FOV: 45 degrees: 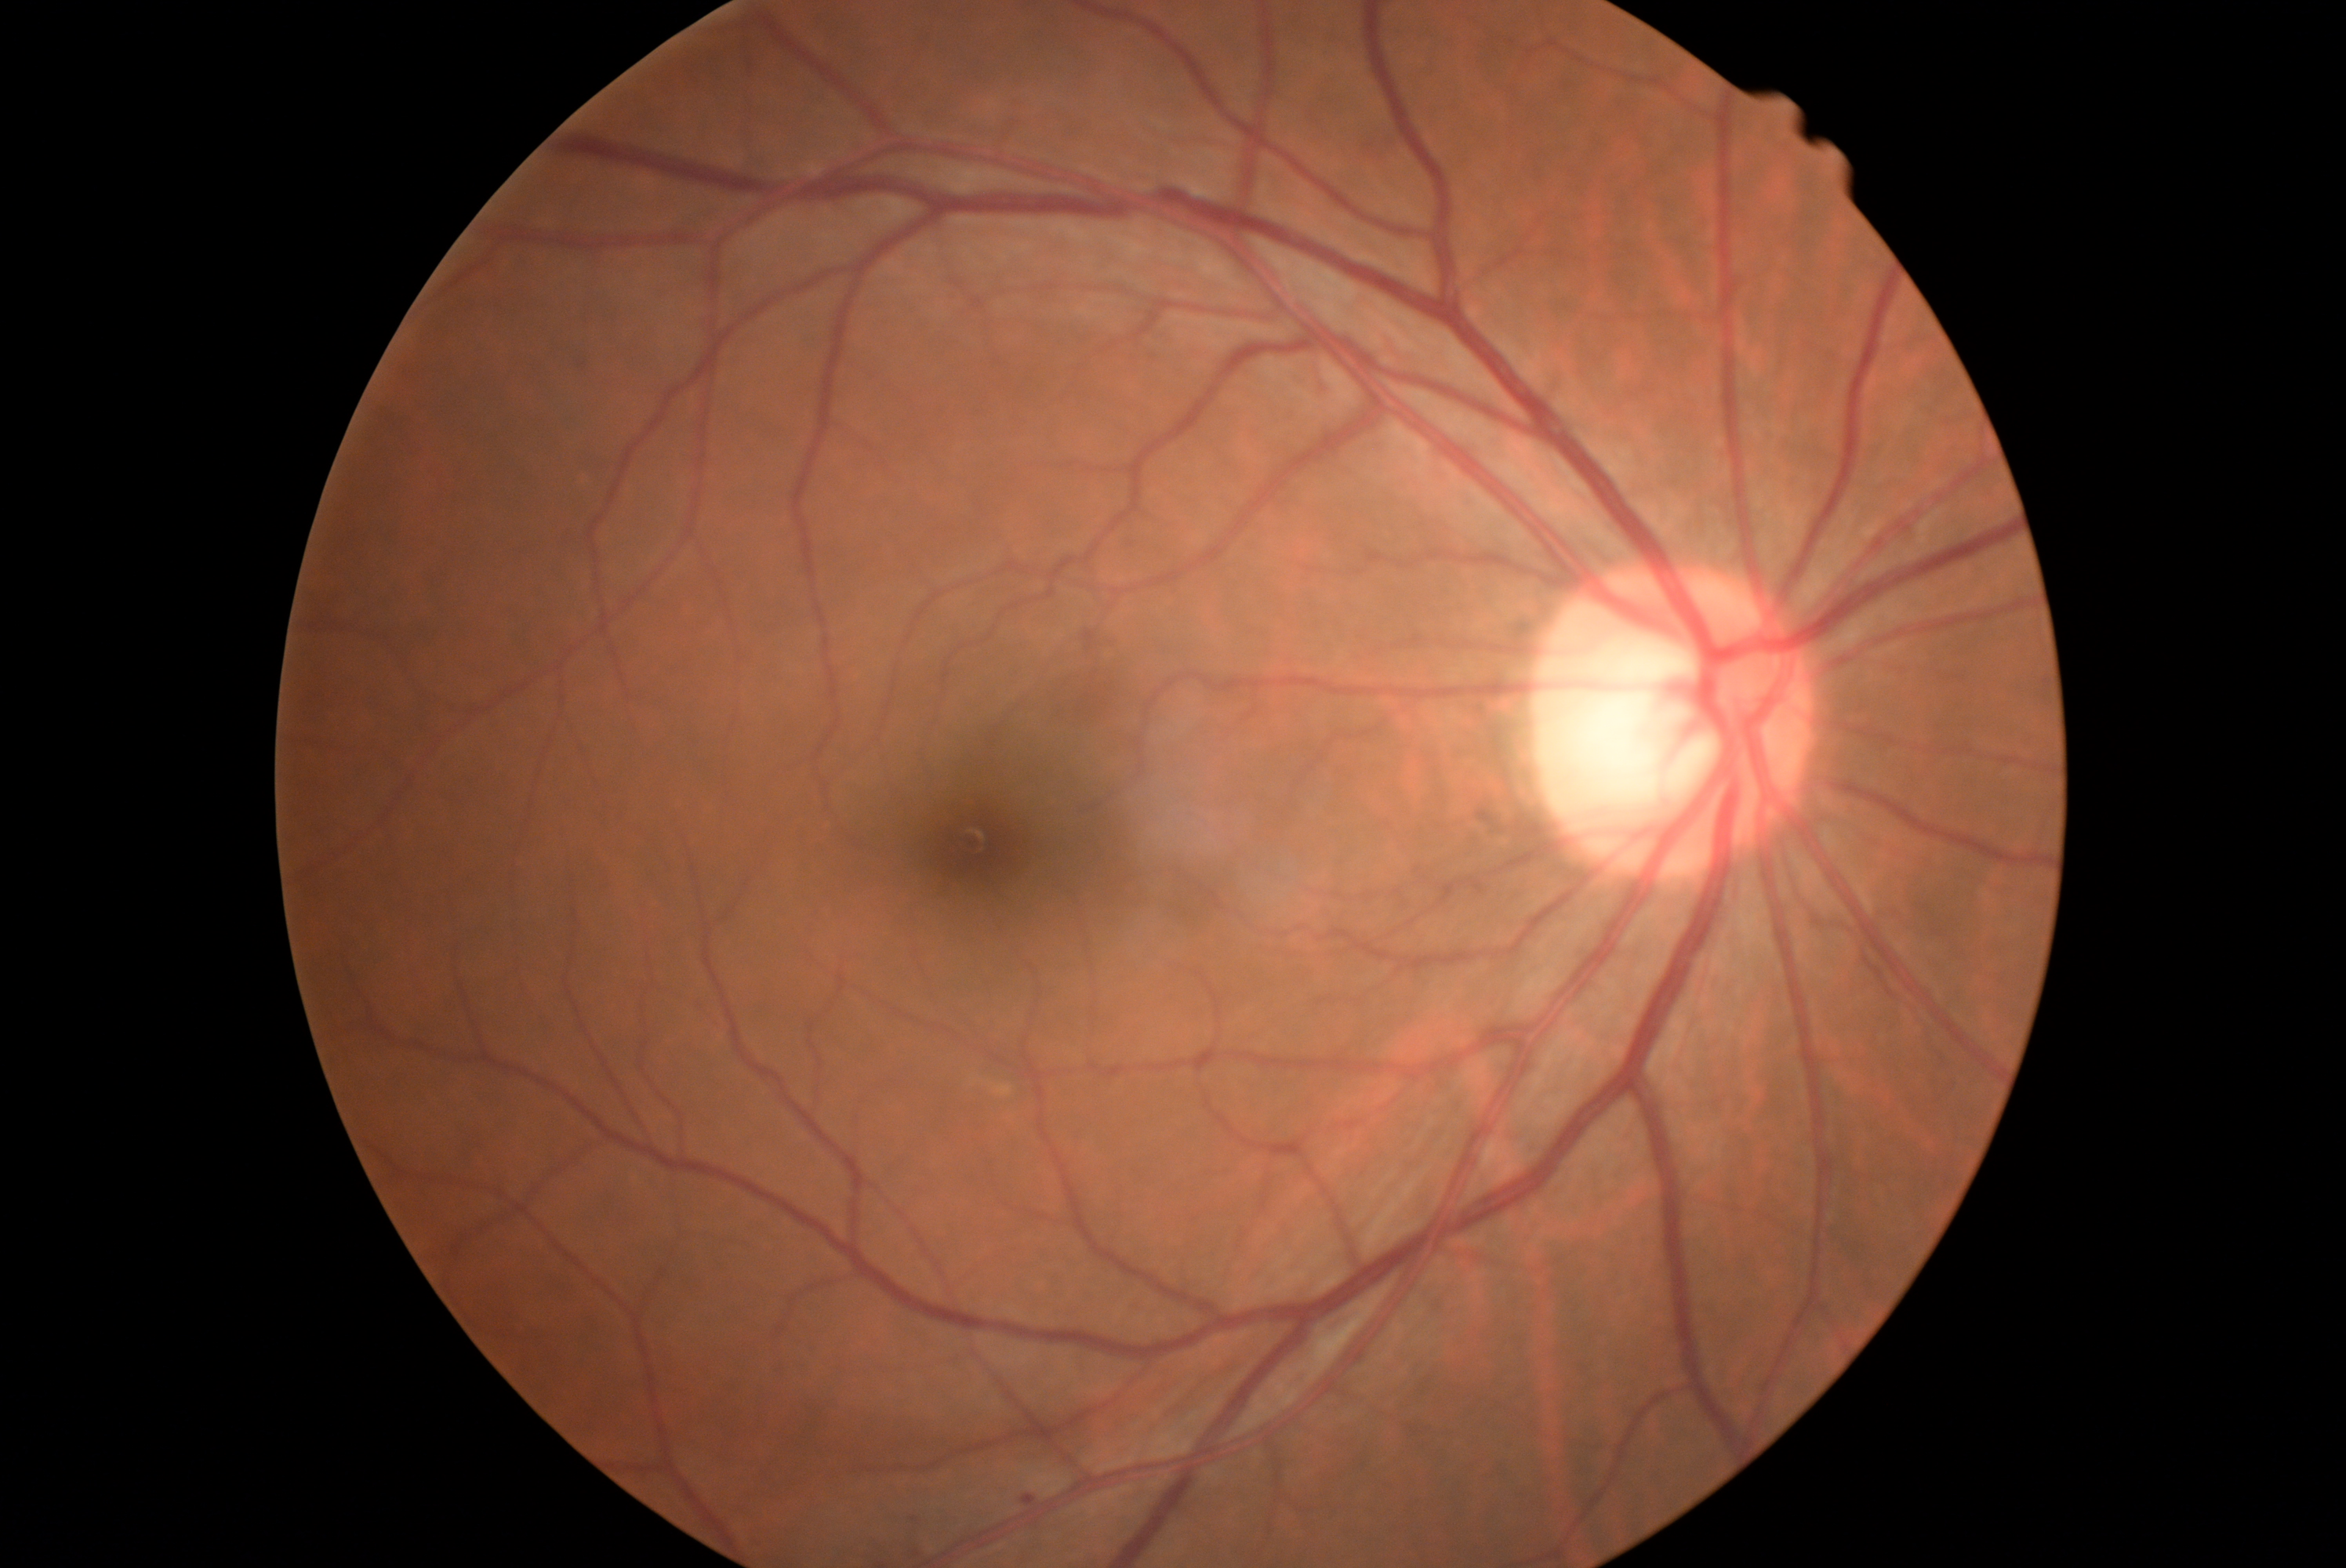 Diabetic retinopathy is 1.